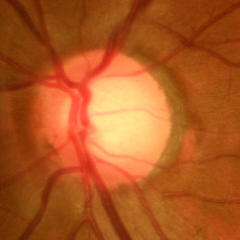 Q: Does this eye have glaucoma?
A: No glaucoma.